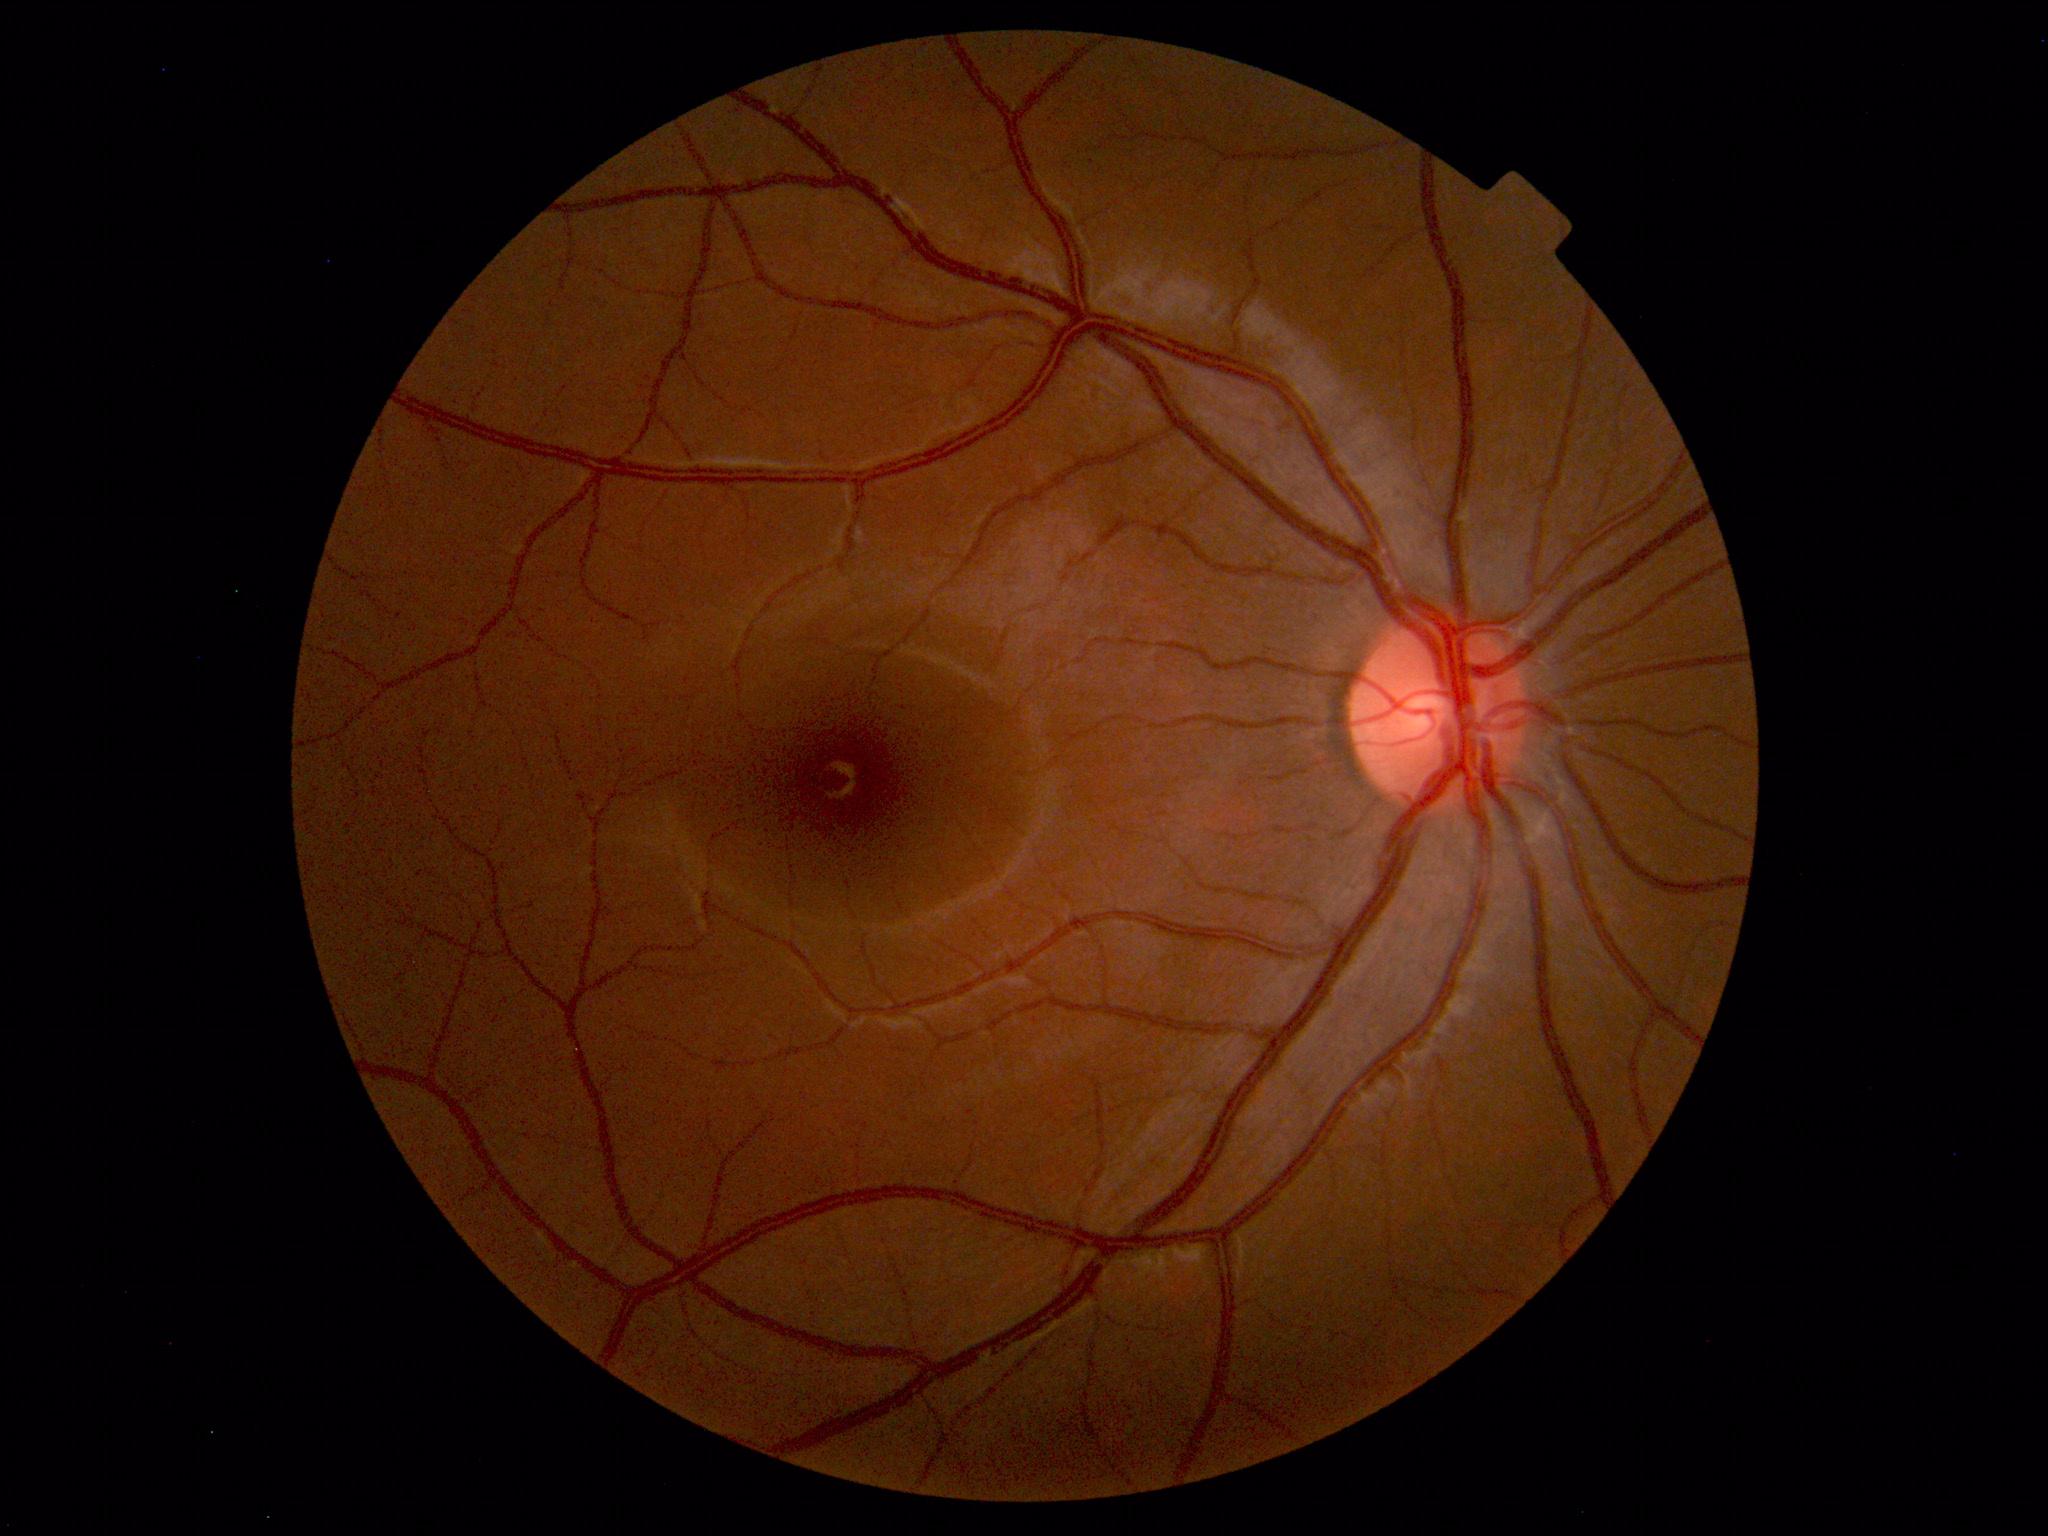

No retinal pathology identified.